Fundus photo · 2048x1536px.
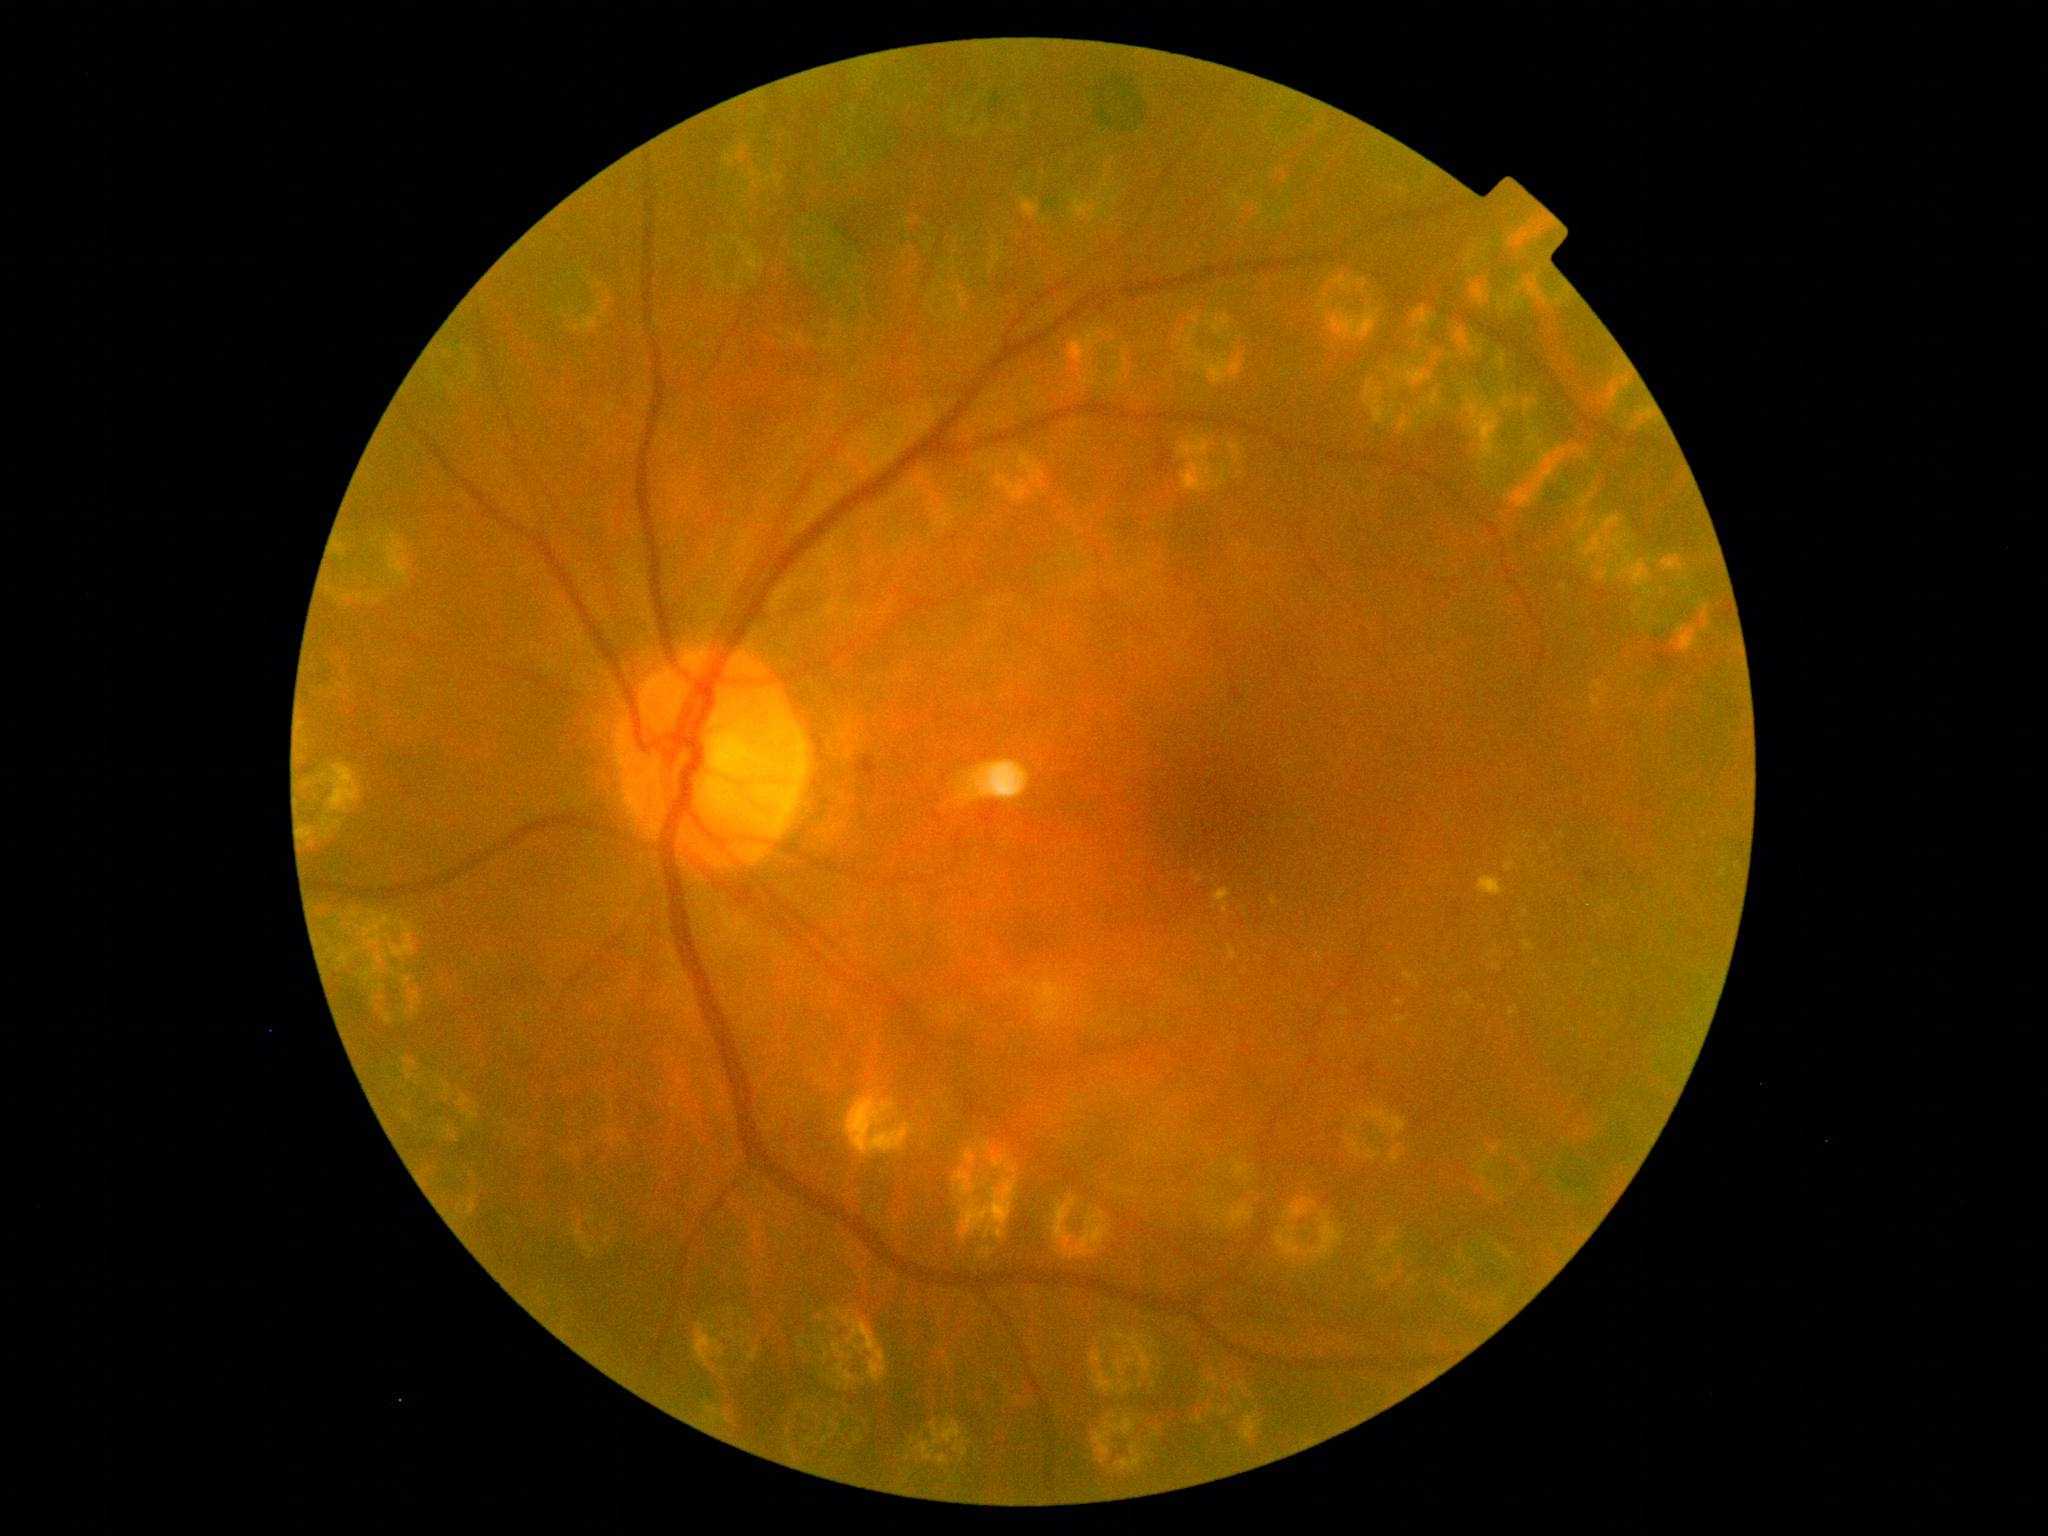 DR stage is 2 — more than just microaneurysms but less than severe NPDR.